Remidio smartphone fundus camera. Fundus photo — 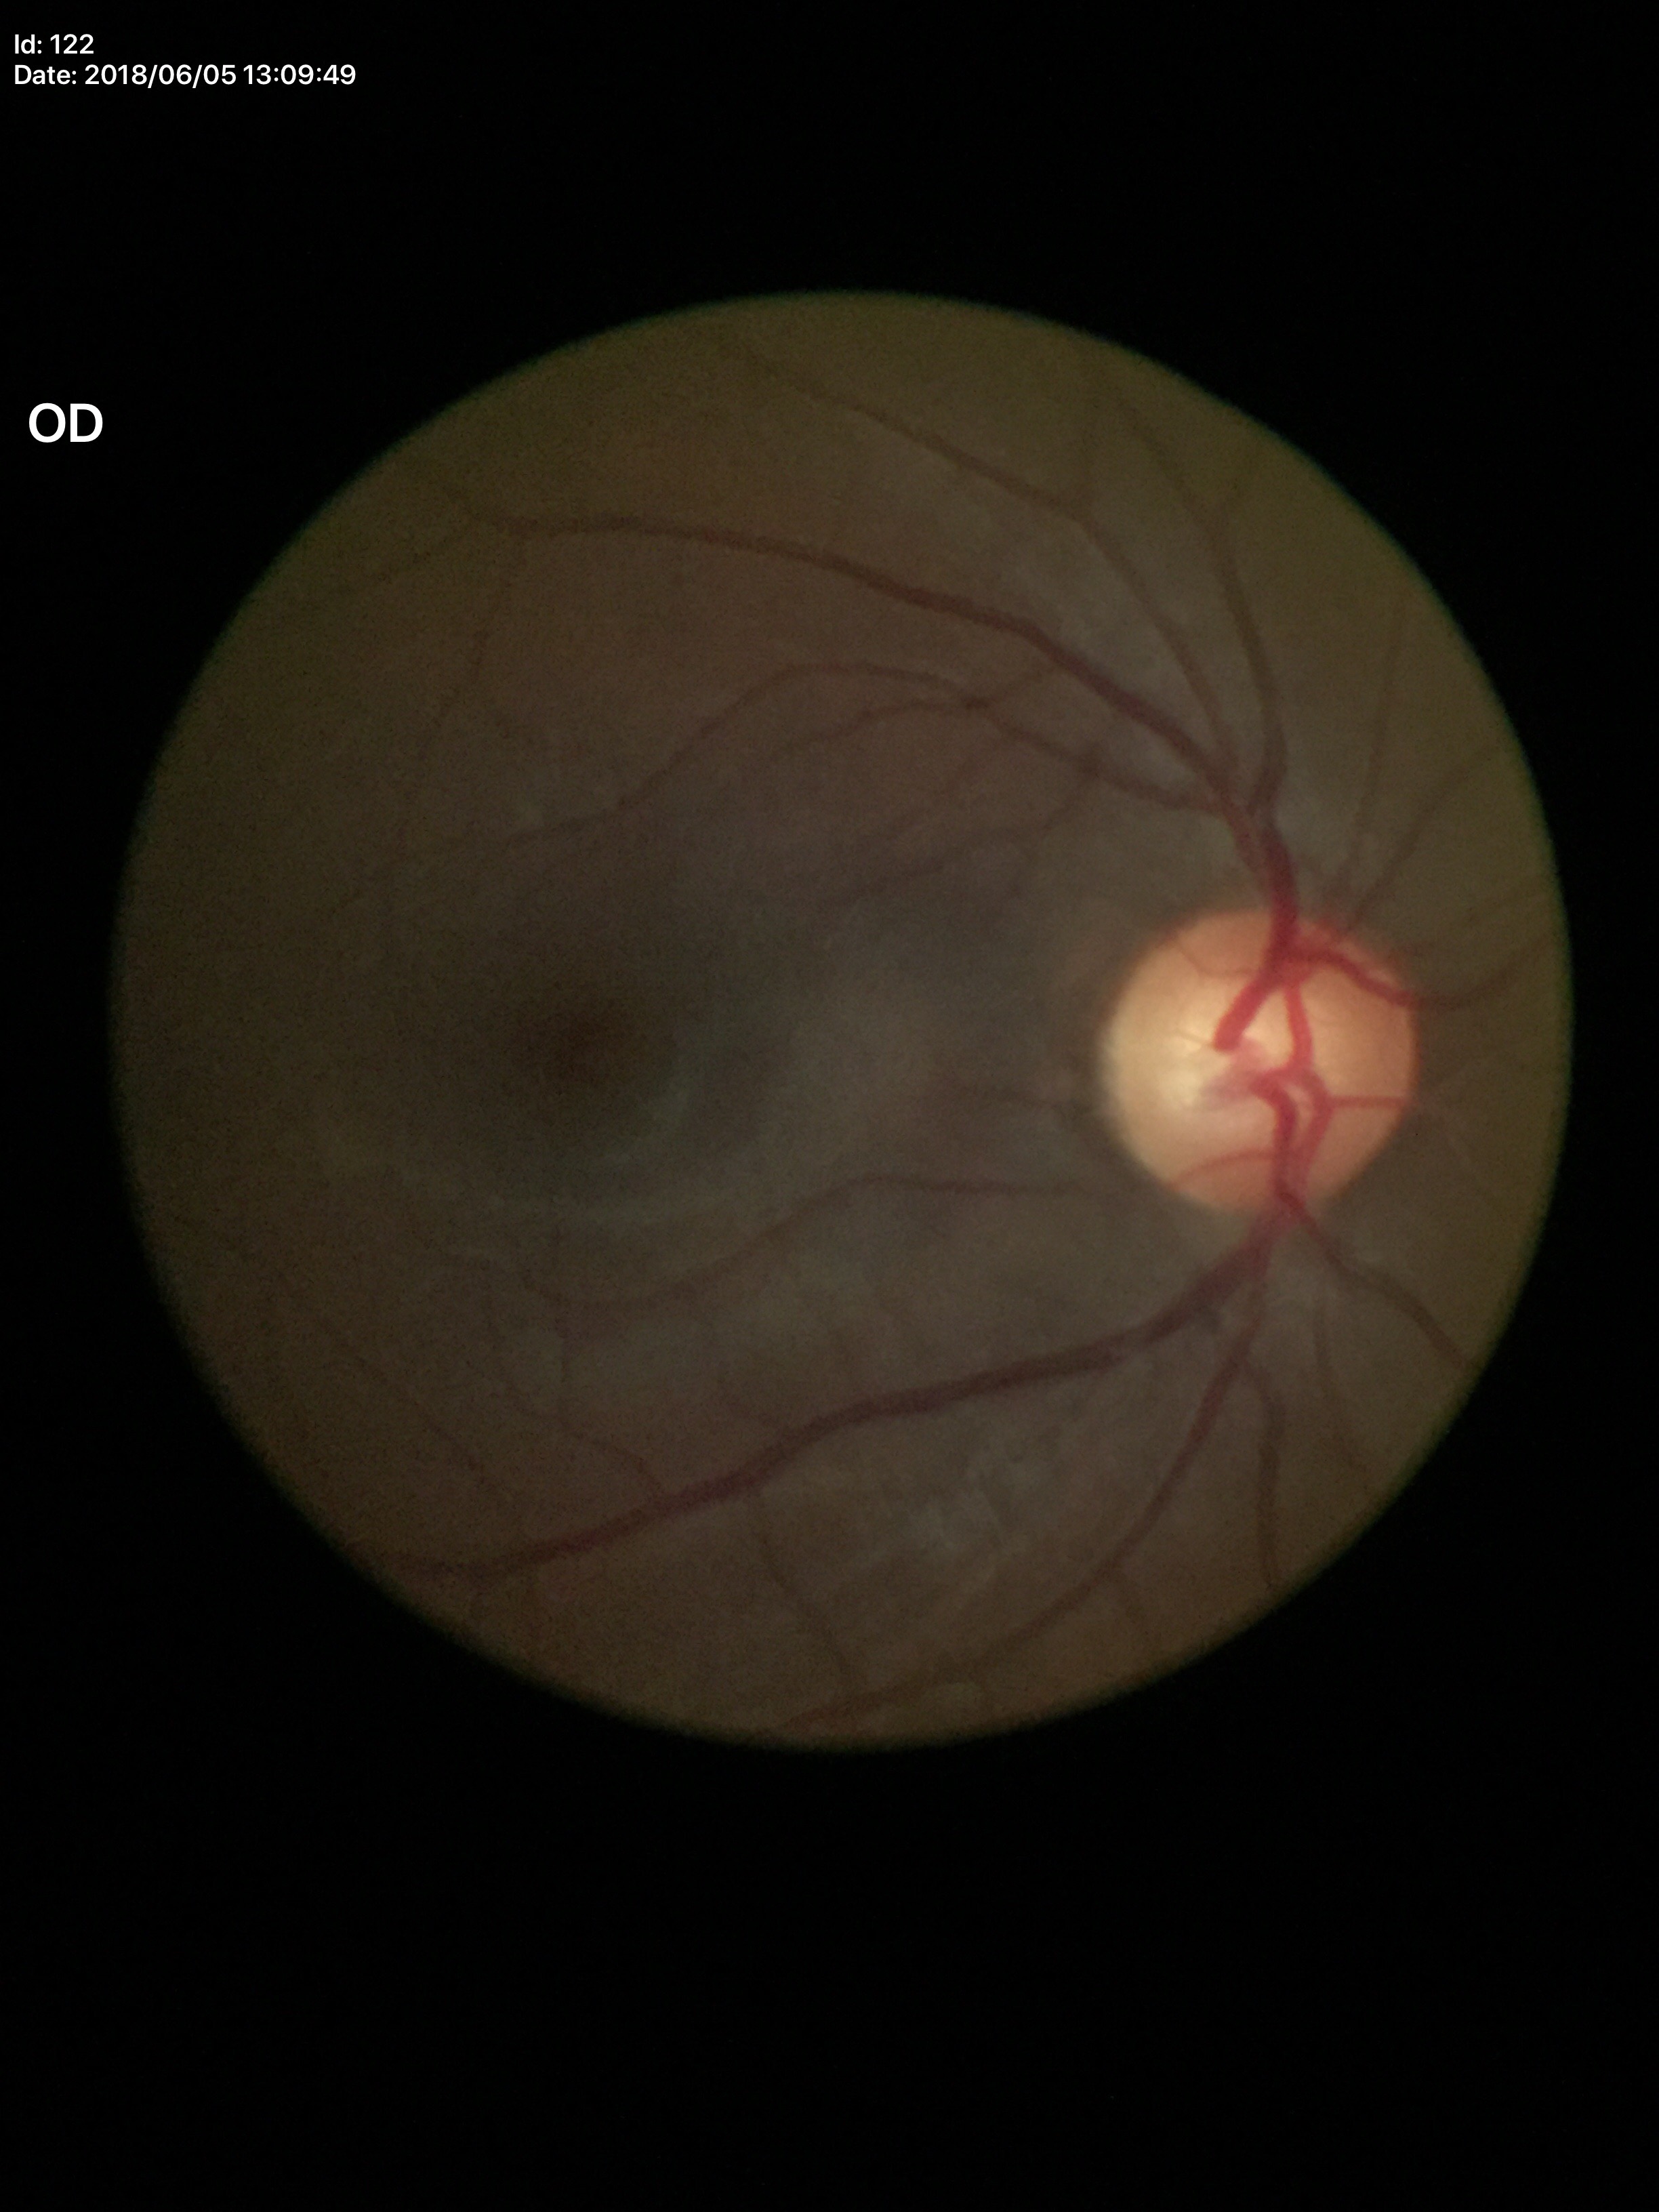
Glaucoma screening = suspect, vertical CDR = 0.59, horizontal CDR = 0.60.